45° FOV · 1624 x 1232 pixels: 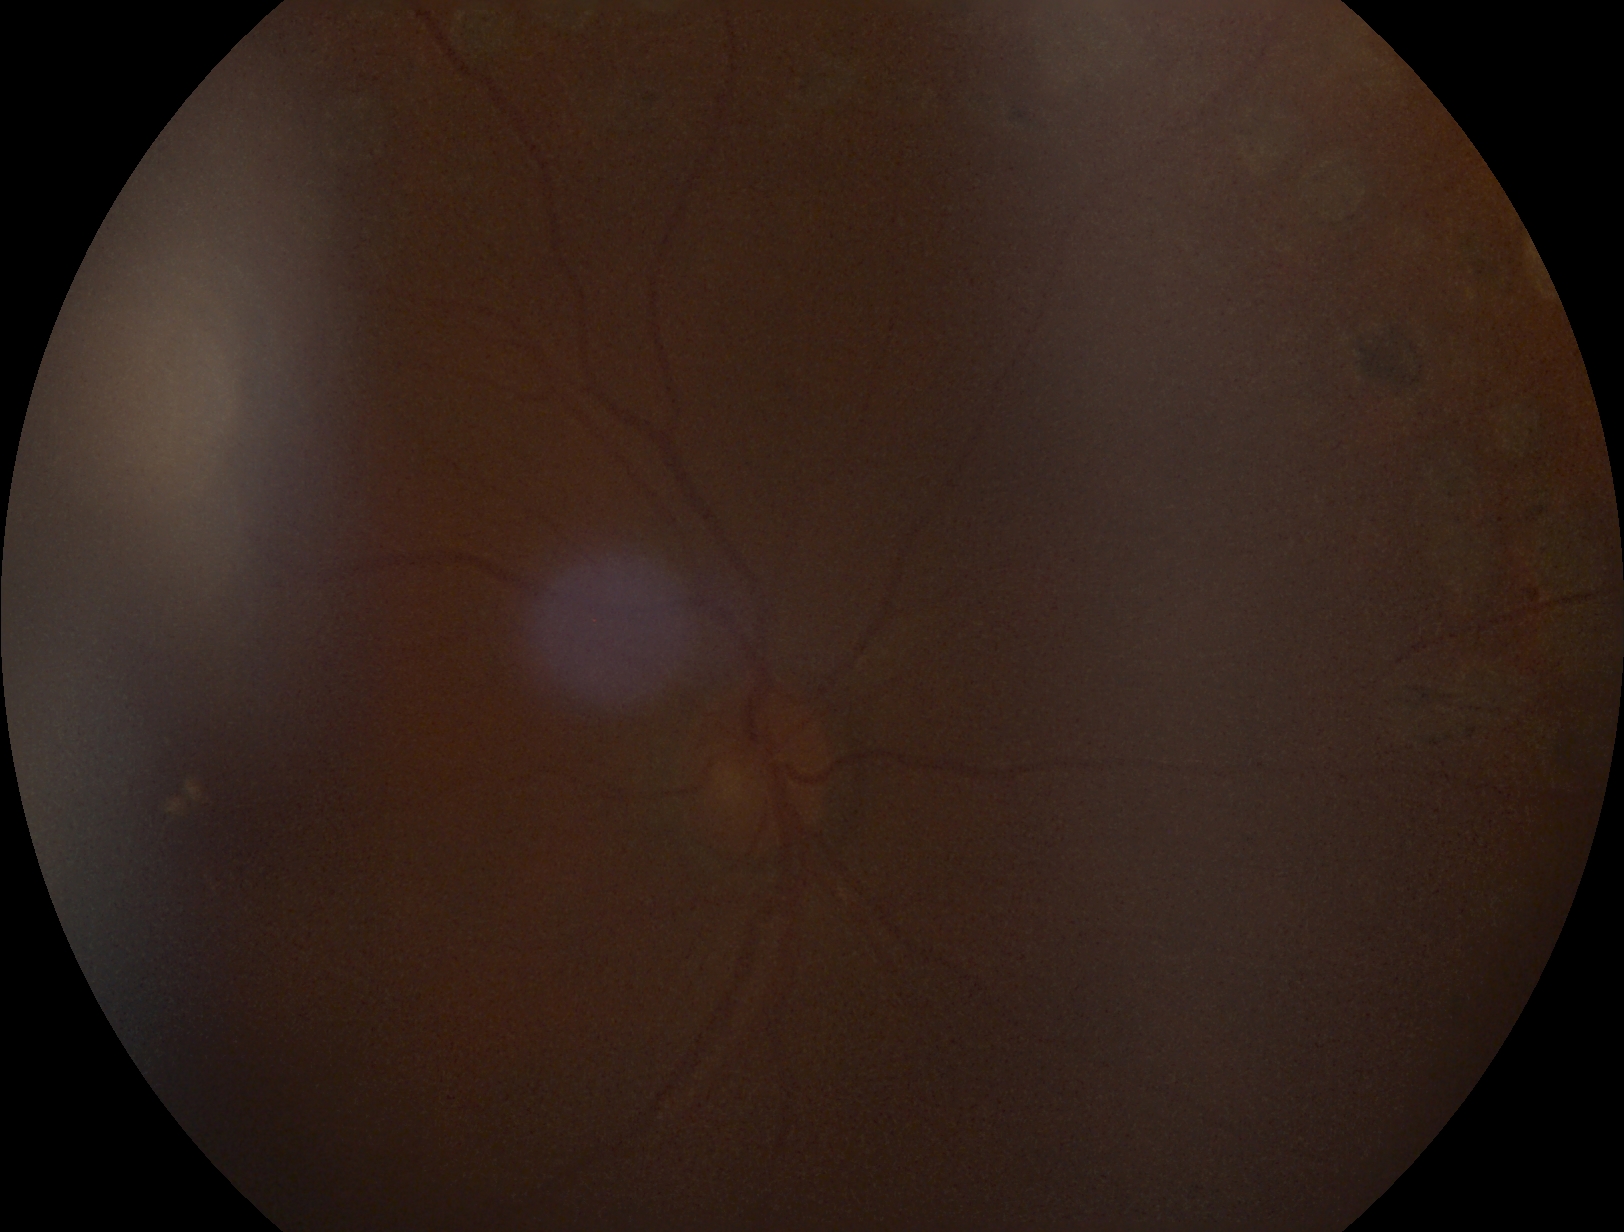

diabetic retinopathy (DR)@ungradable.